45-degree field of view:
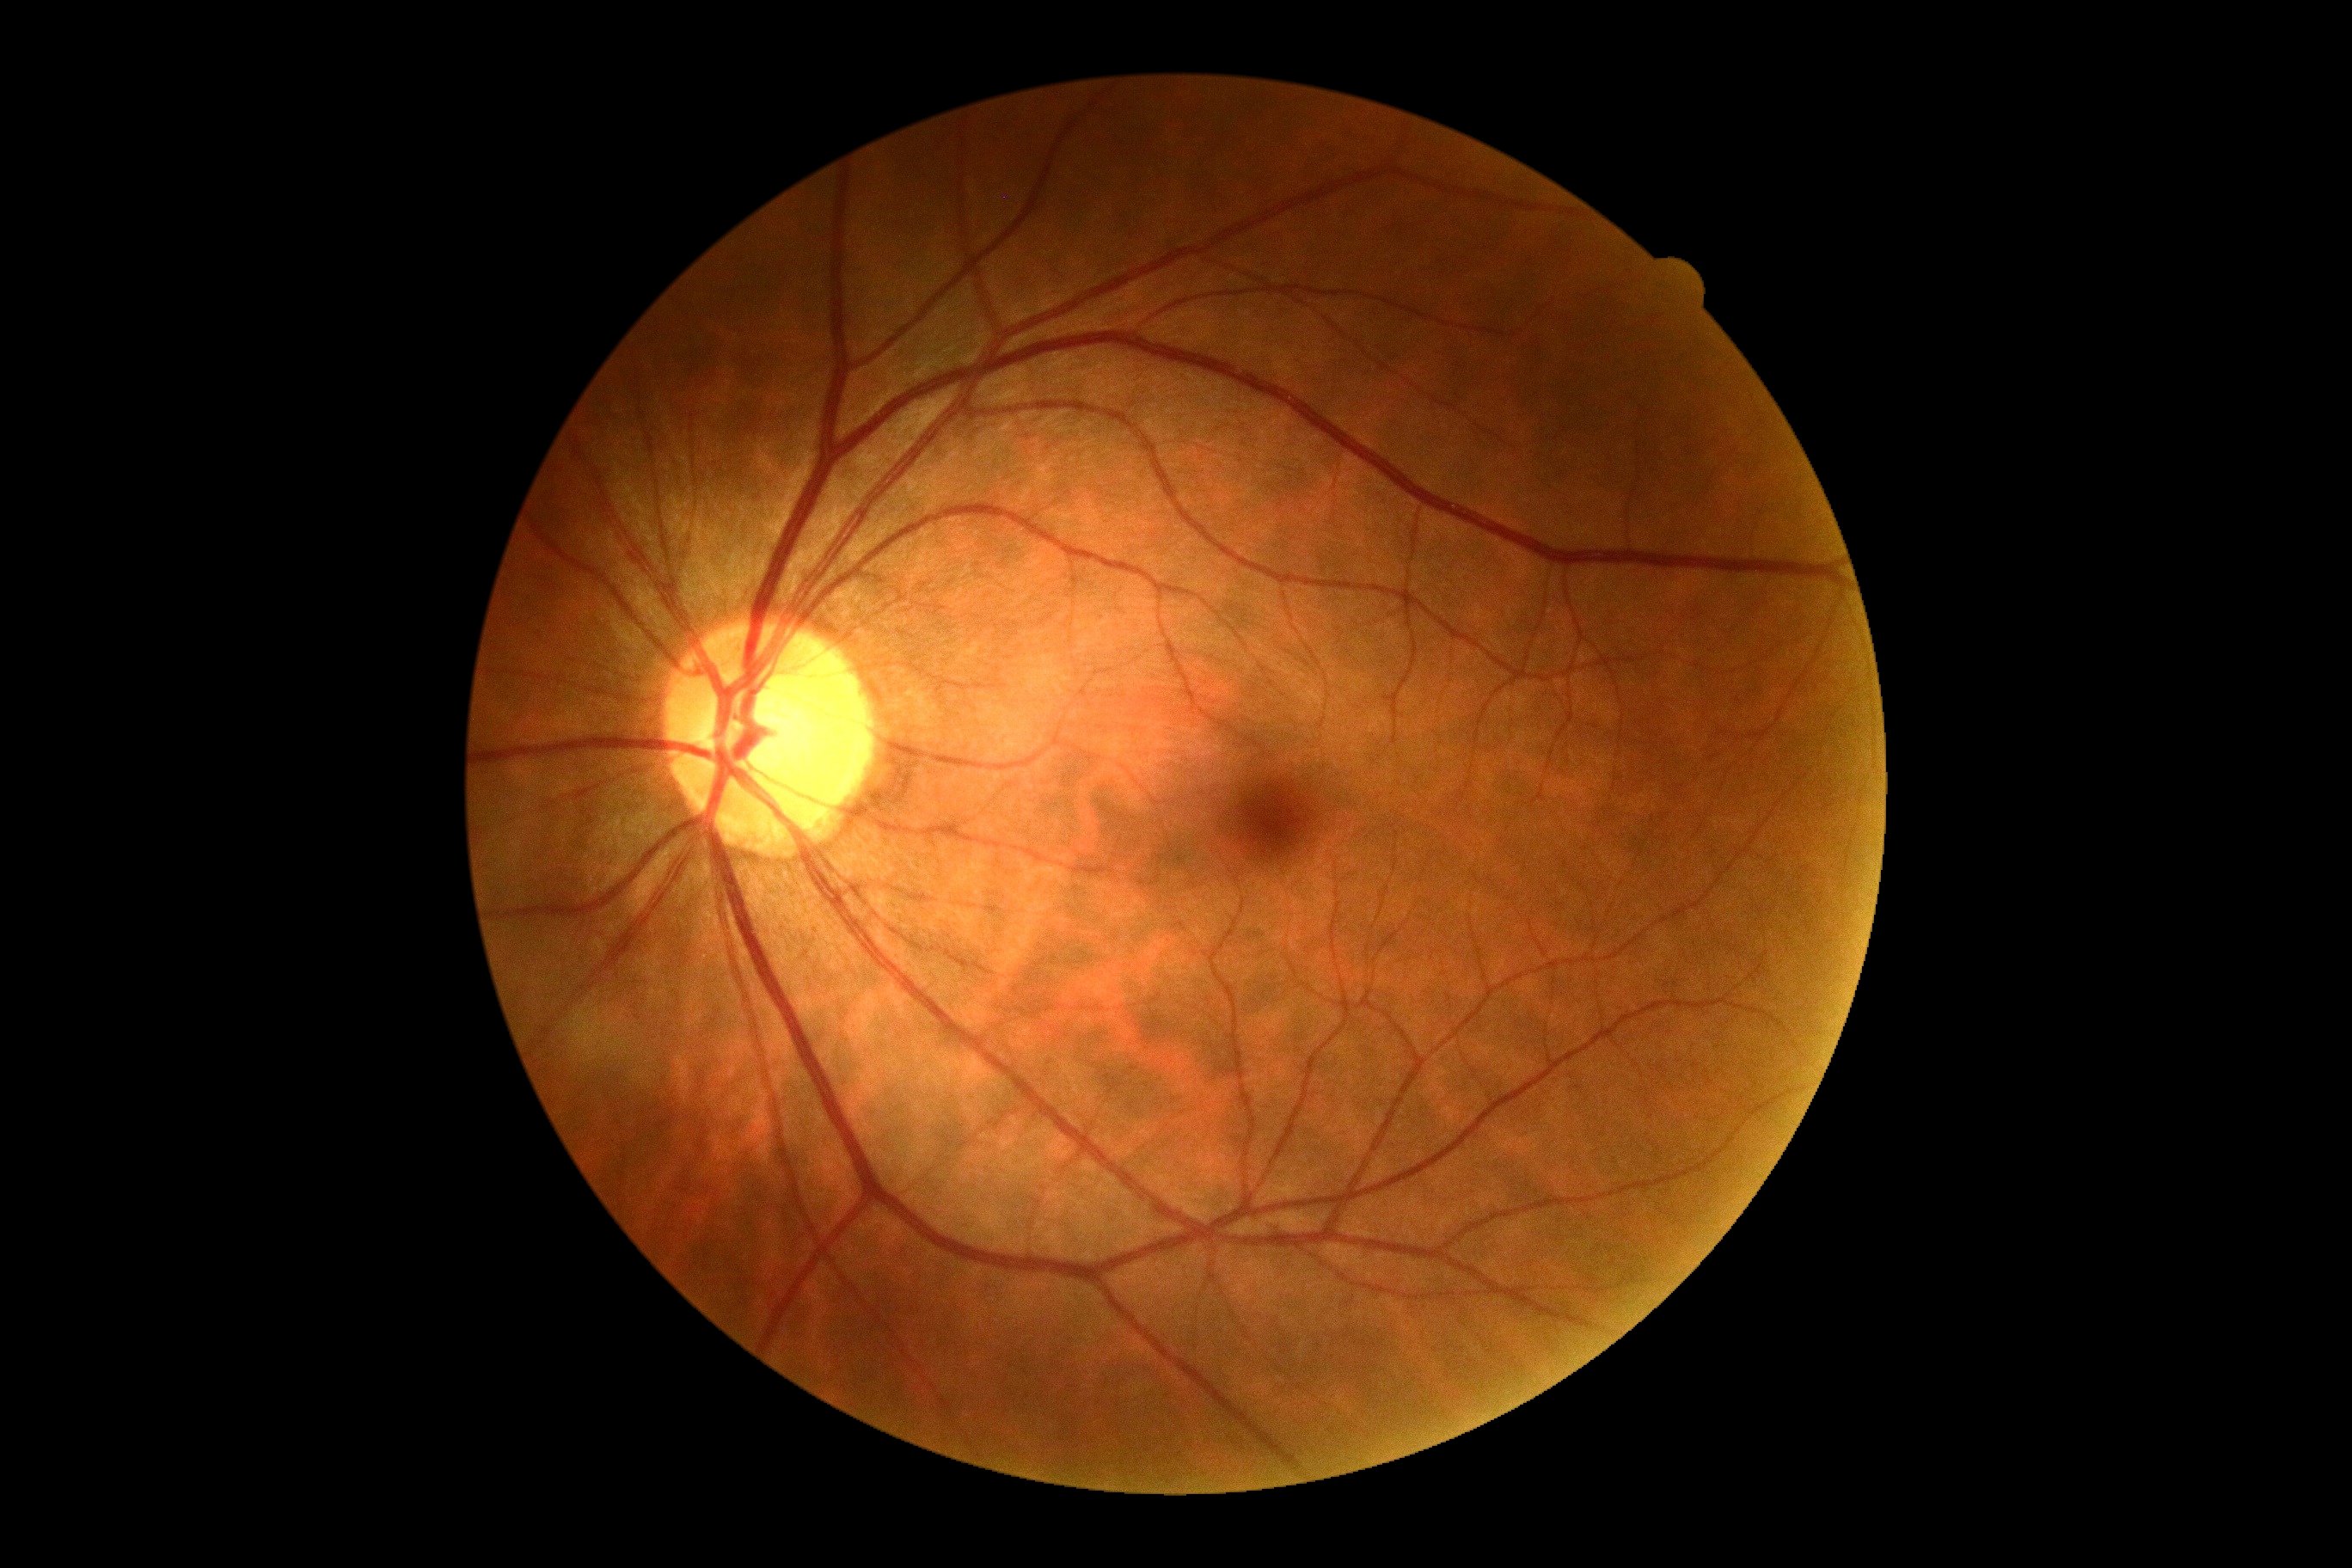

{
  "dr_grade": "grade 0"
}